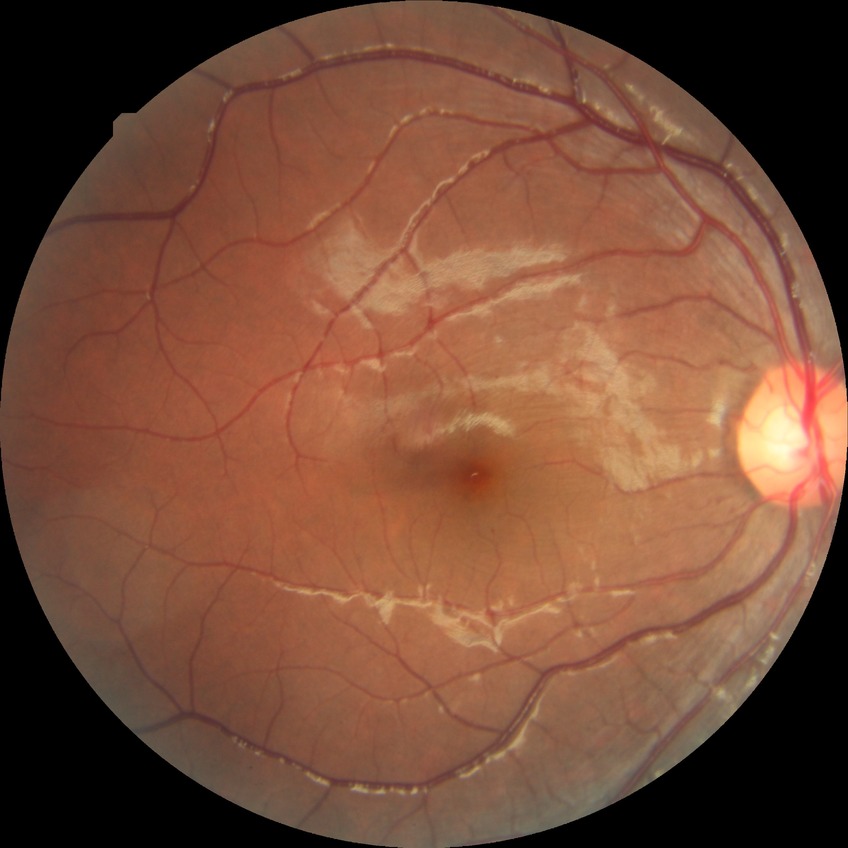 retinopathy stage=simple diabetic retinopathy.